2352 x 1568 pixels
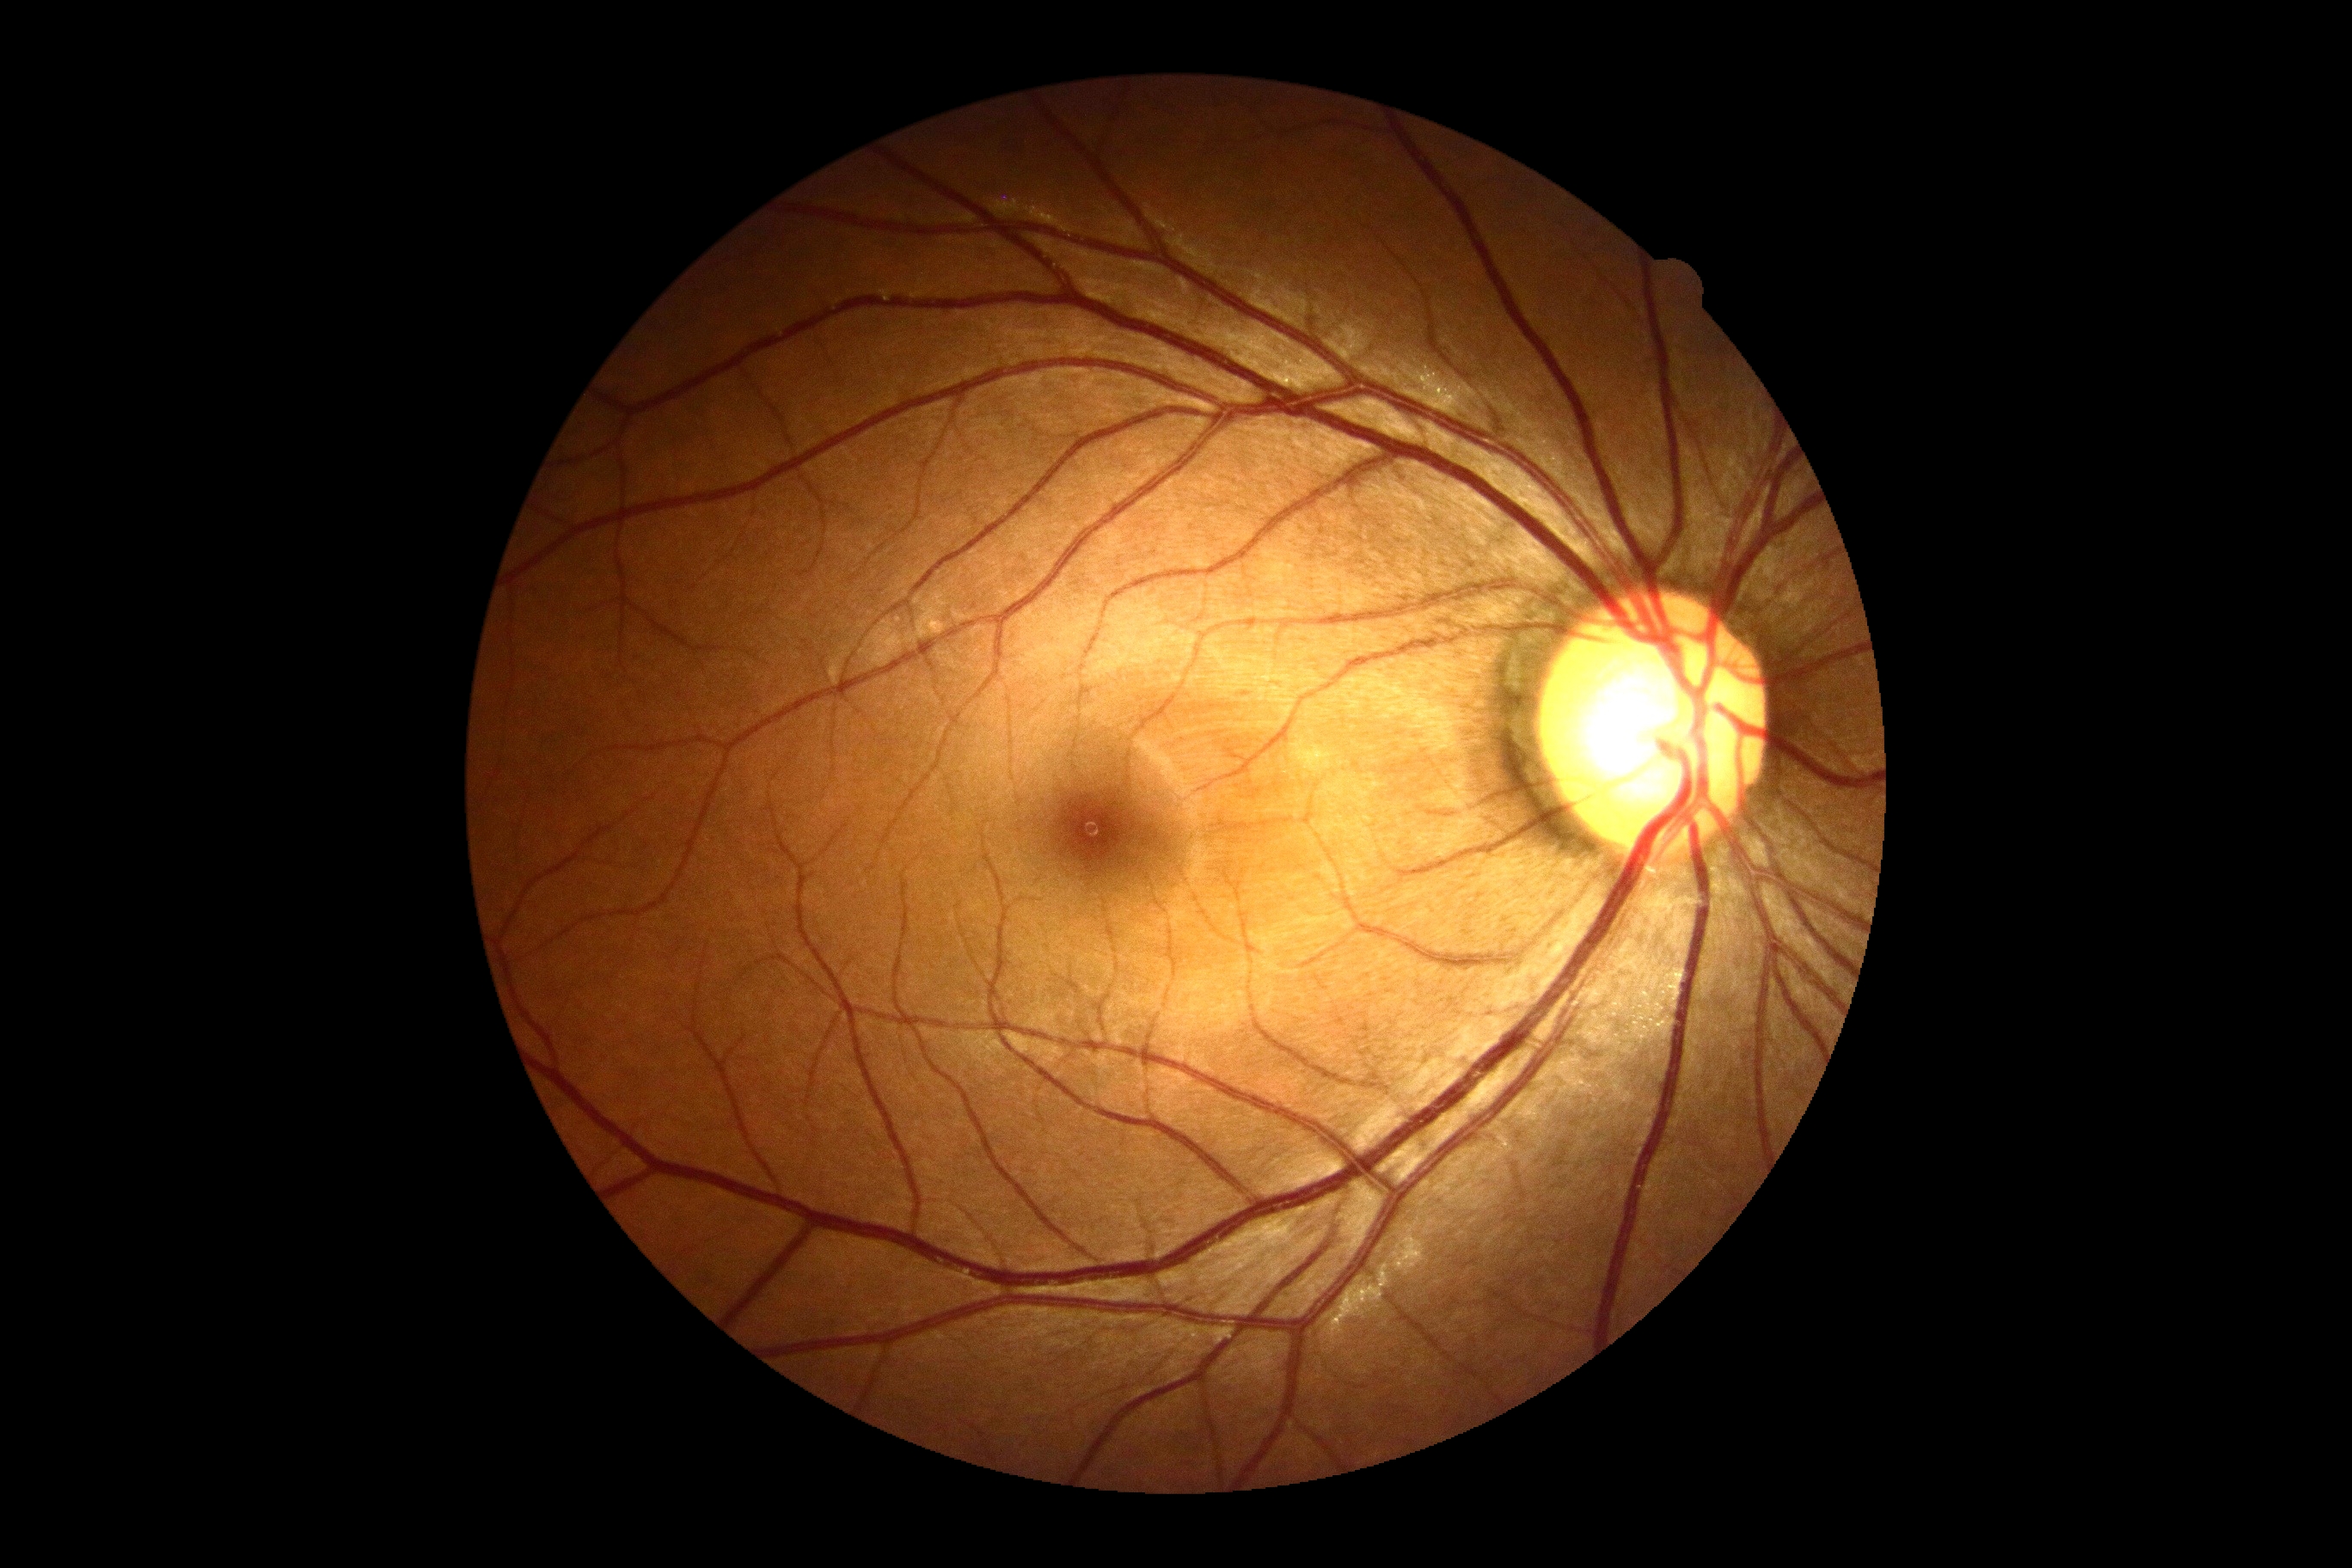

No apparent diabetic retinopathy. Retinopathy: no apparent diabetic retinopathy (grade 0) — no visible signs of diabetic retinopathy.